Centered on the macula:
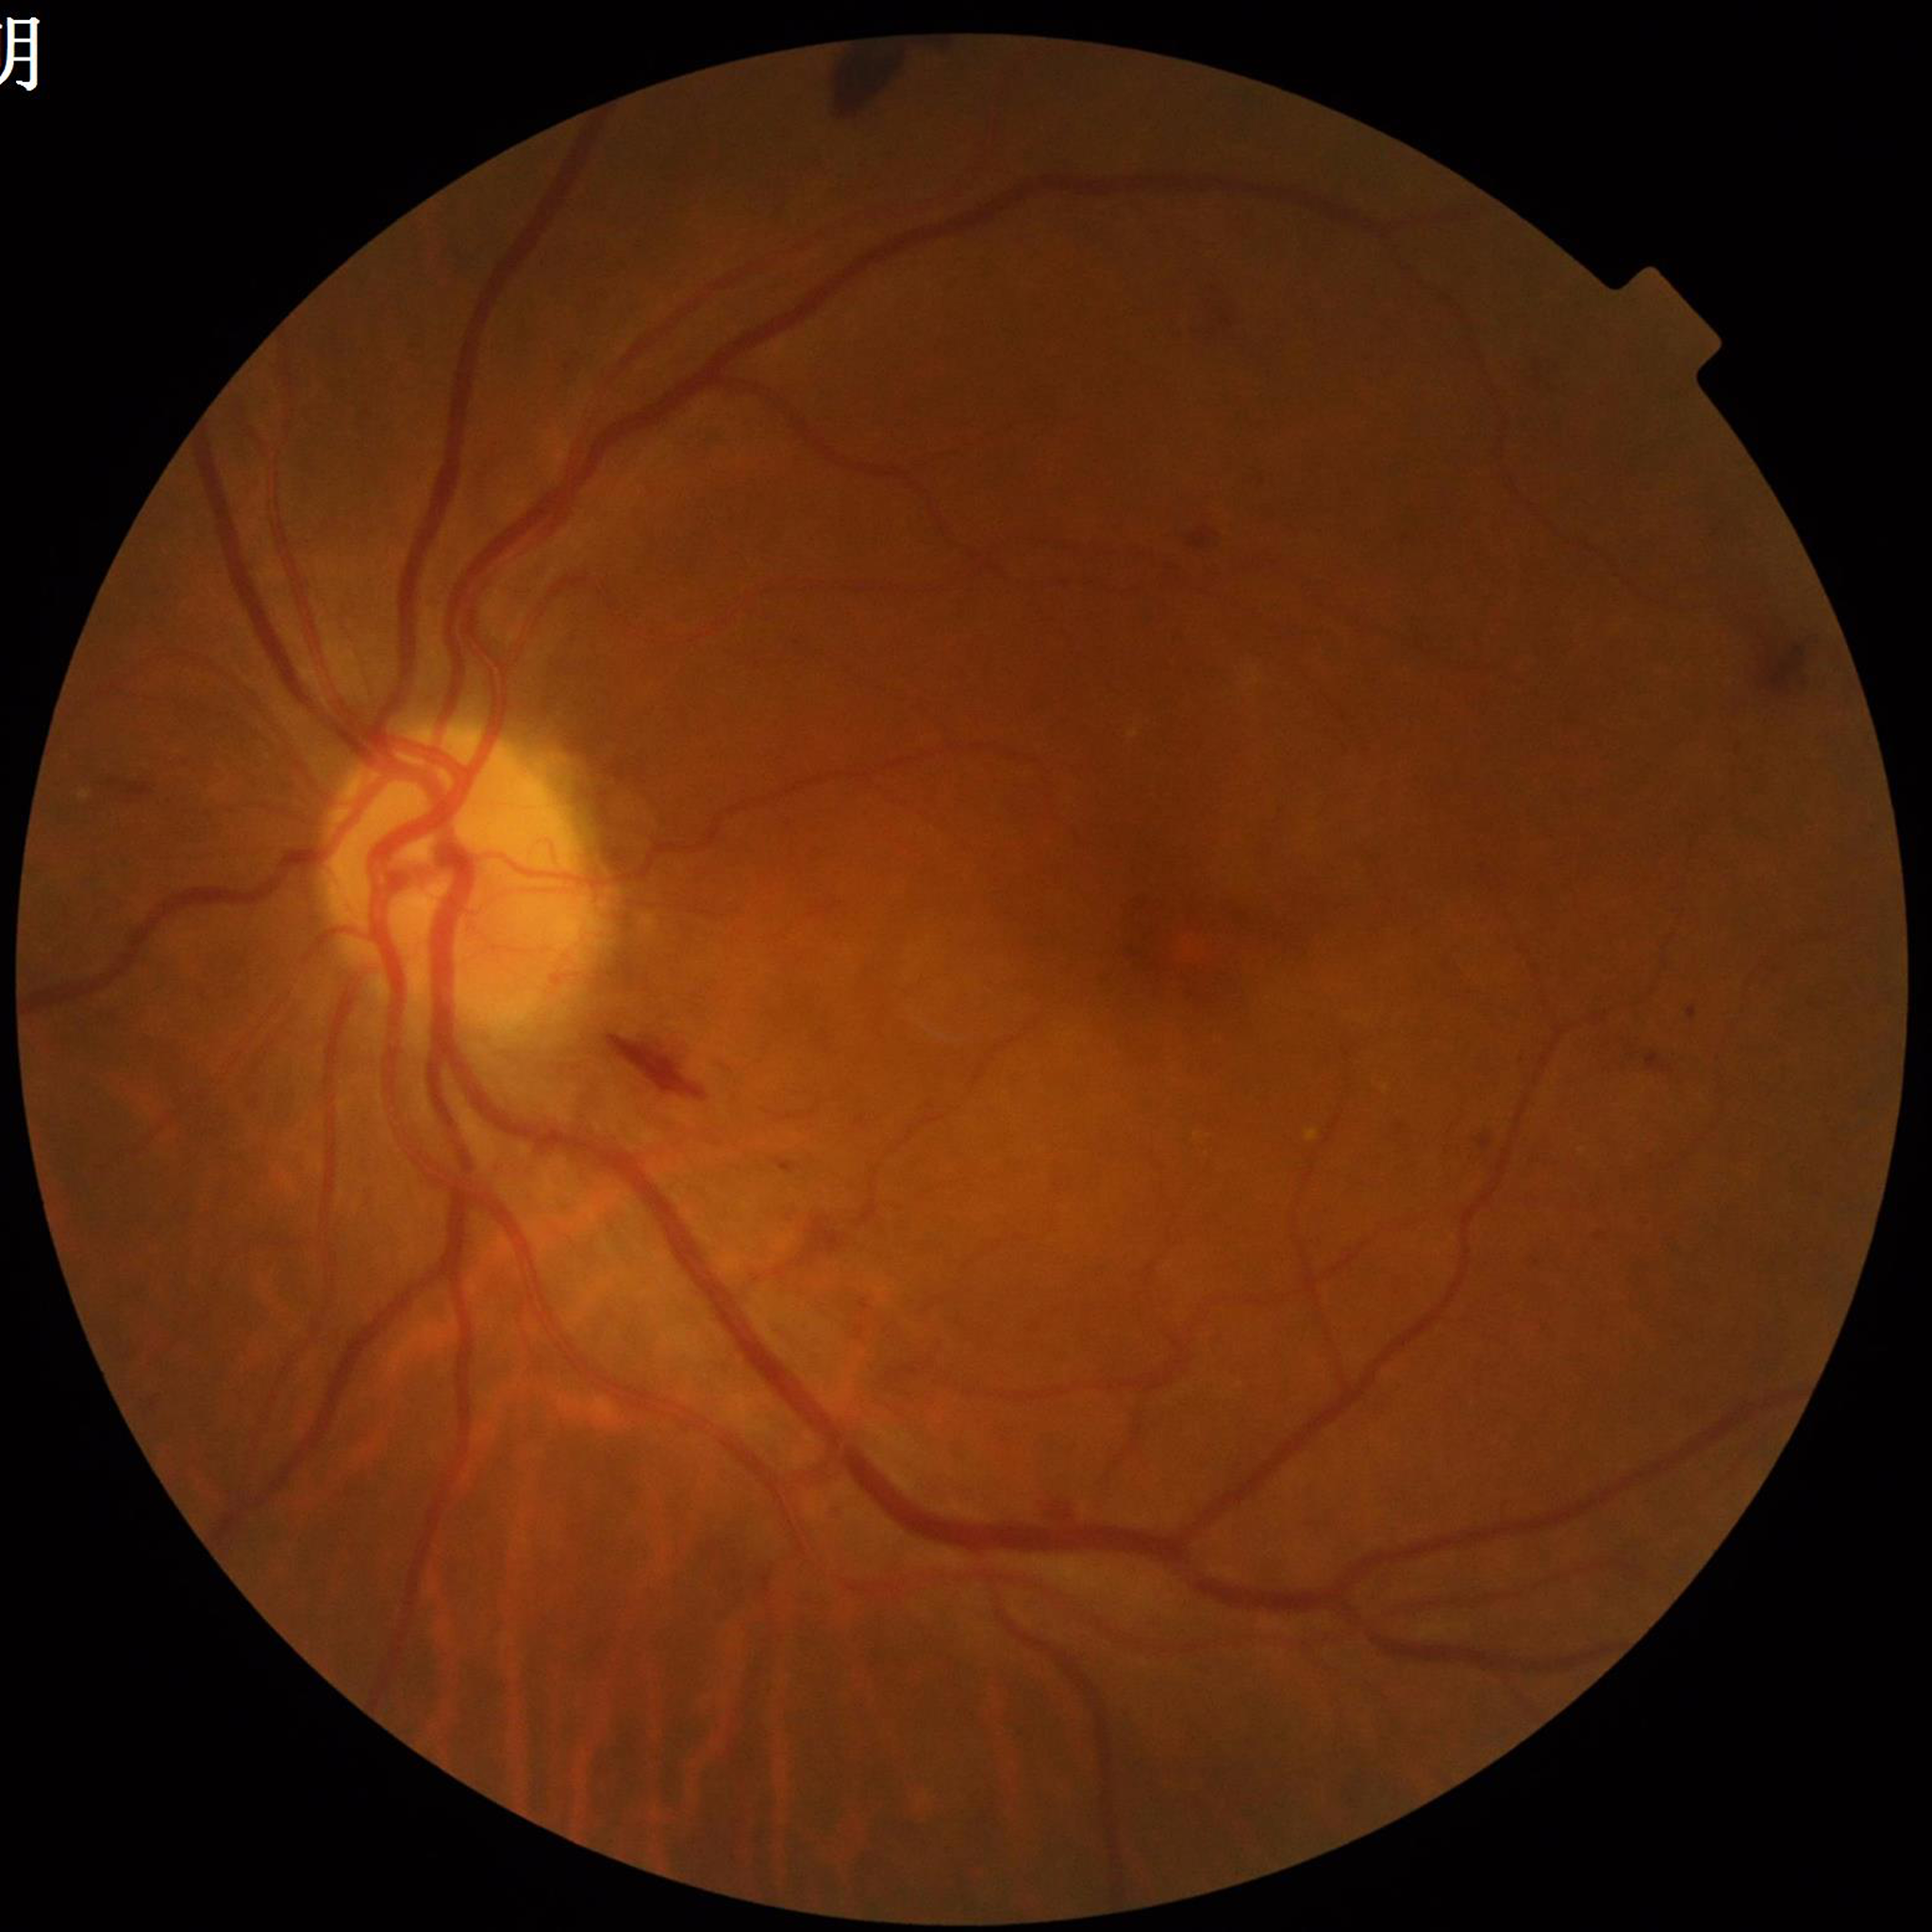 Color fundus photo. Patient diagnosed with diabetic retinopathy (DR).